Color fundus image. 2048x1536: 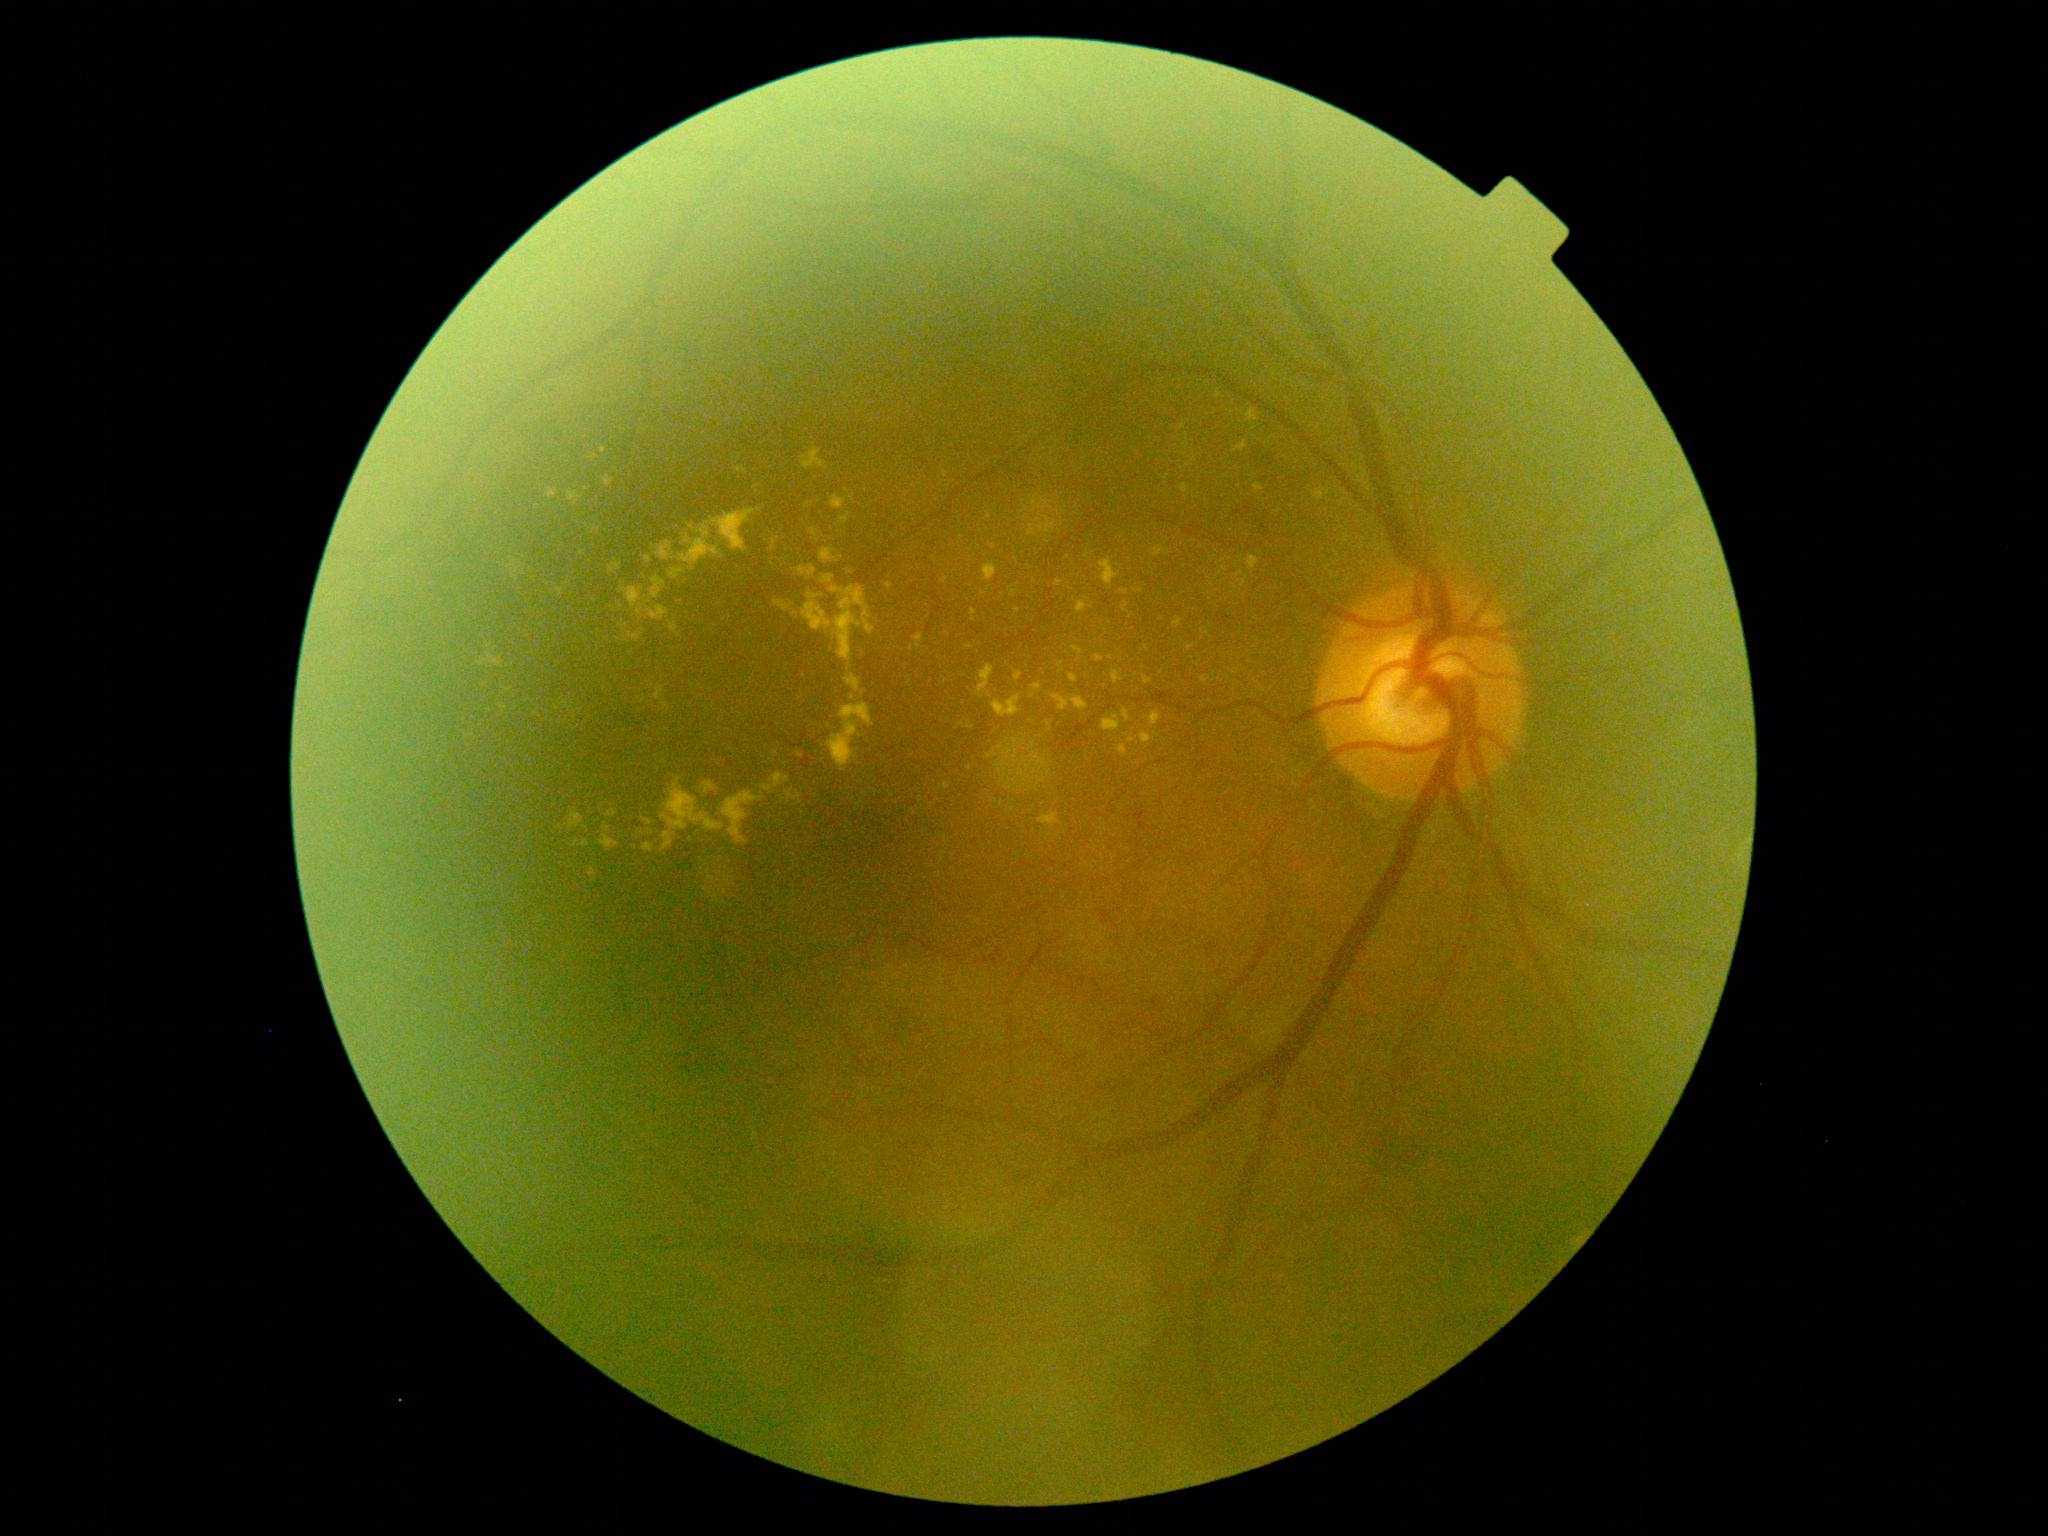

DR grade: moderate NPDR (2).